Pediatric retinal photograph (wide-field): 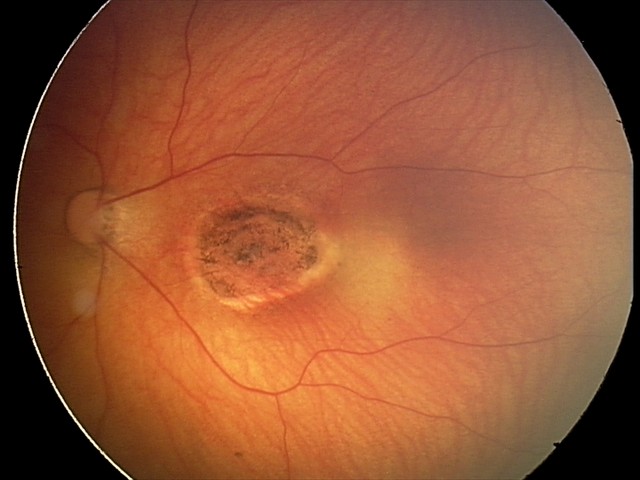 Diagnosis = toxoplasmosis chorioretinitis.